1504x1000px — 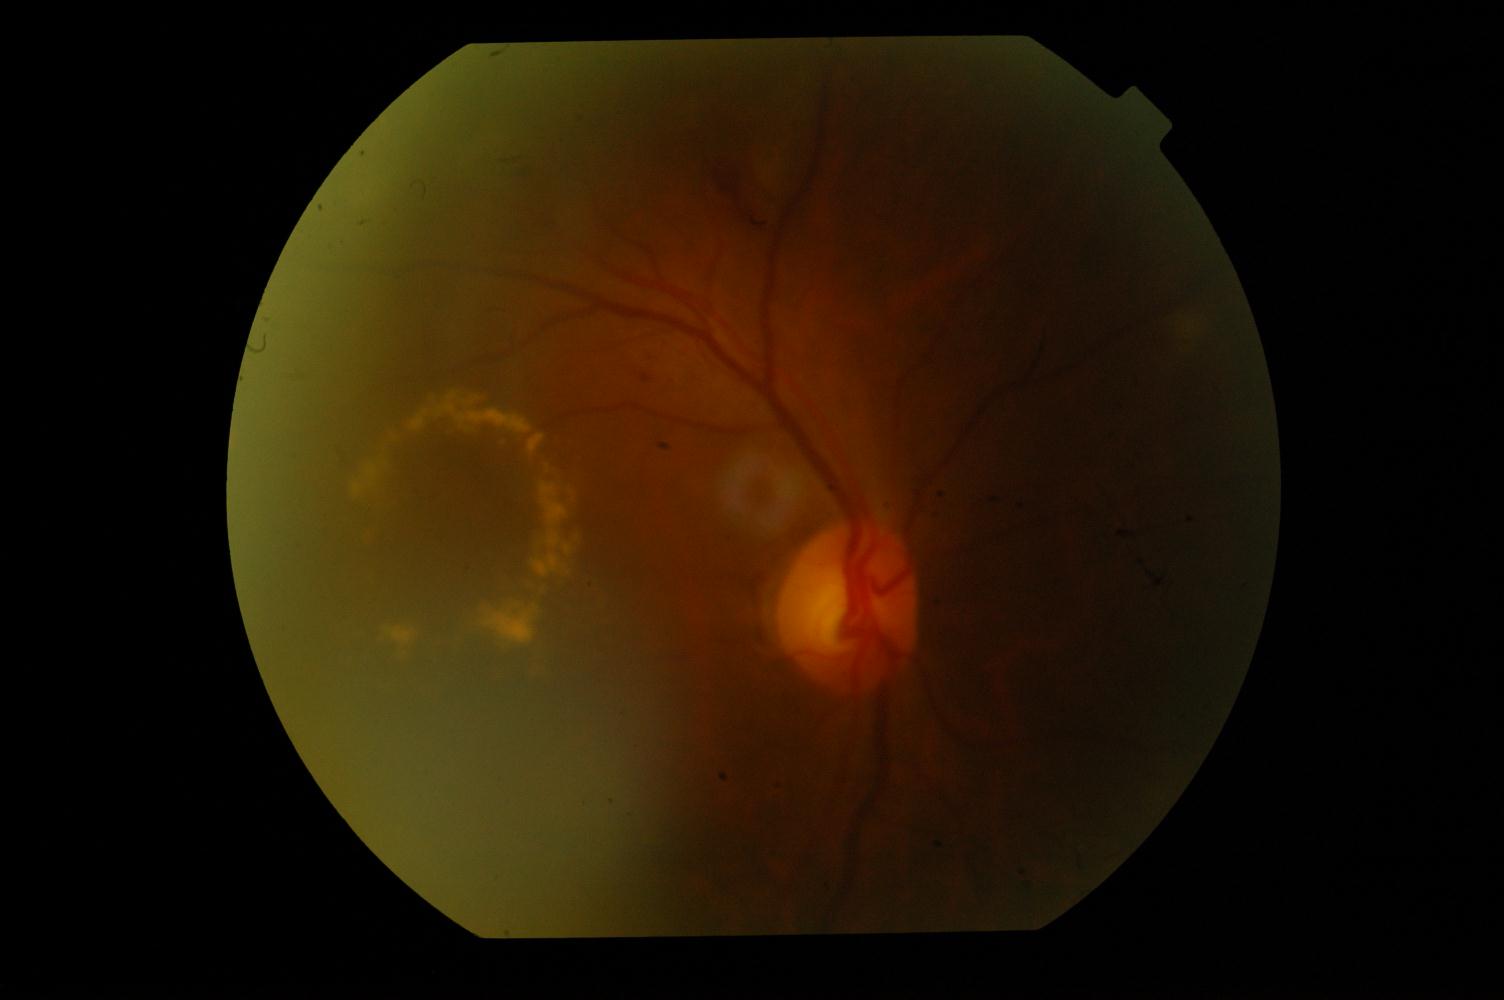

Abnormalities: DR (diabetic retinopathy).